50° FOV
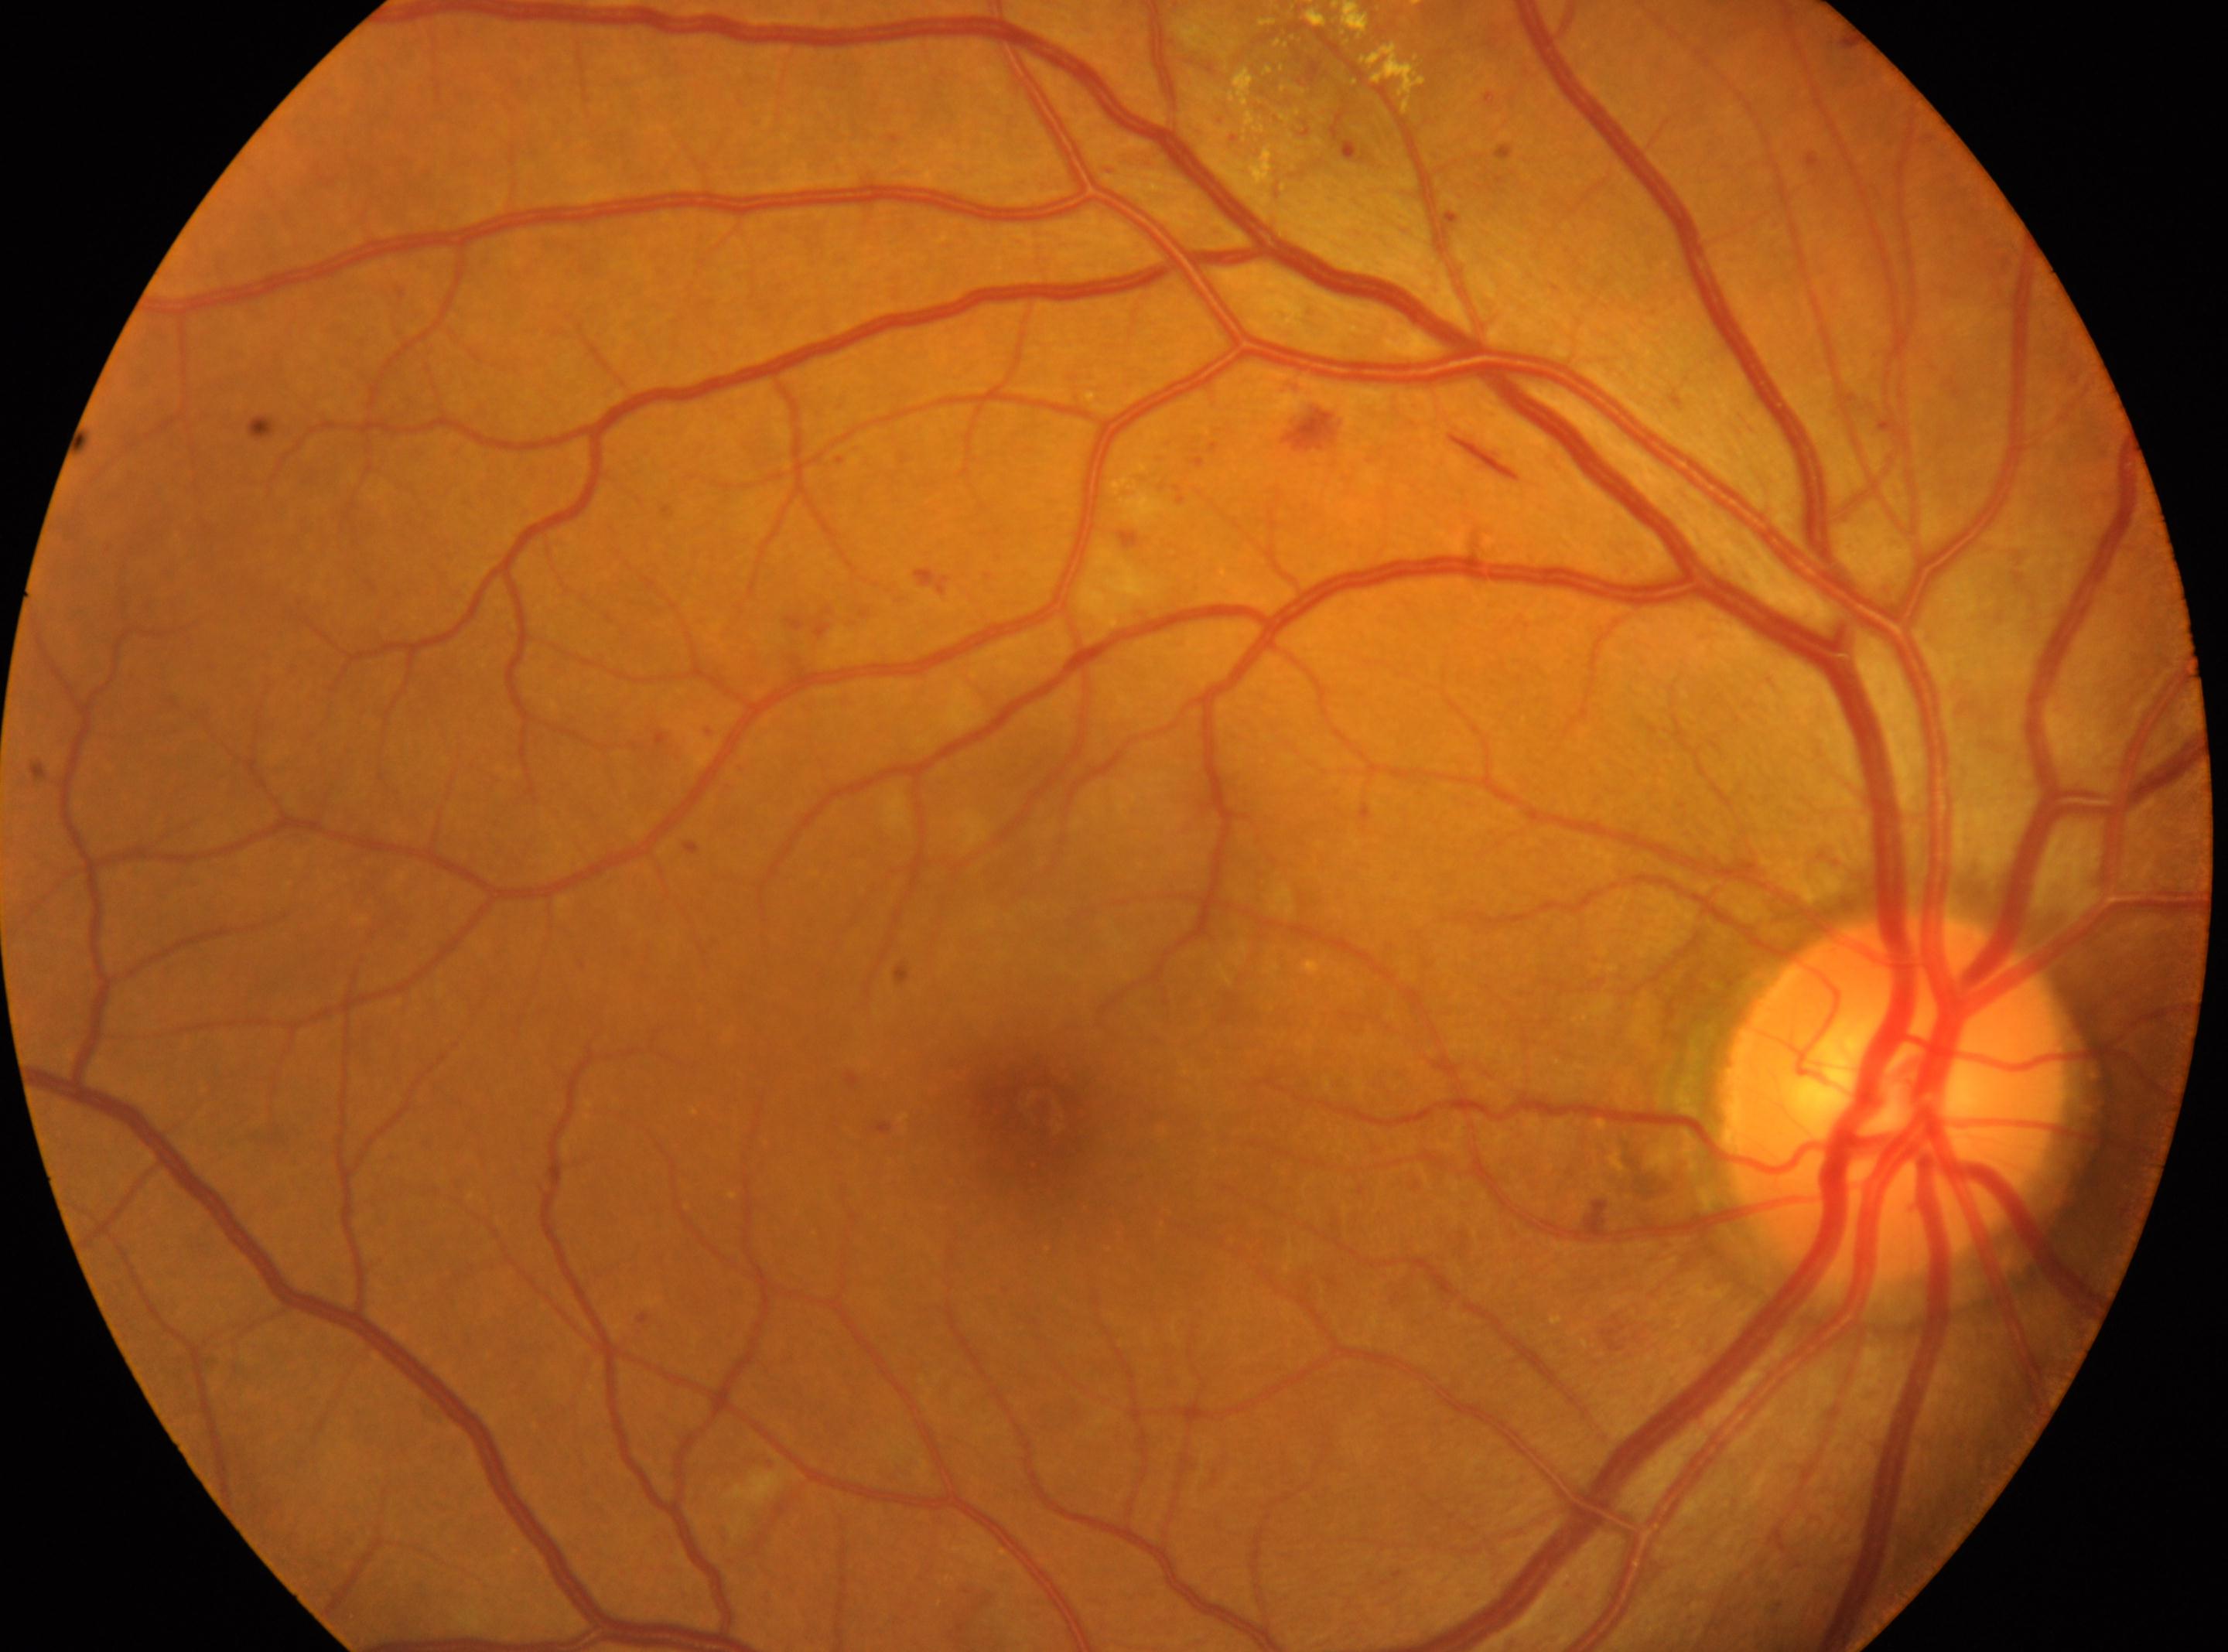 Q: Where is the fovea?
A: (x: 1040, y: 1117)
Q: What is the laterality?
A: OD
Q: Optic disc center?
A: (x: 1895, y: 1101)
Q: Diabetic retinopathy severity?
A: grade 2 (moderate NPDR)